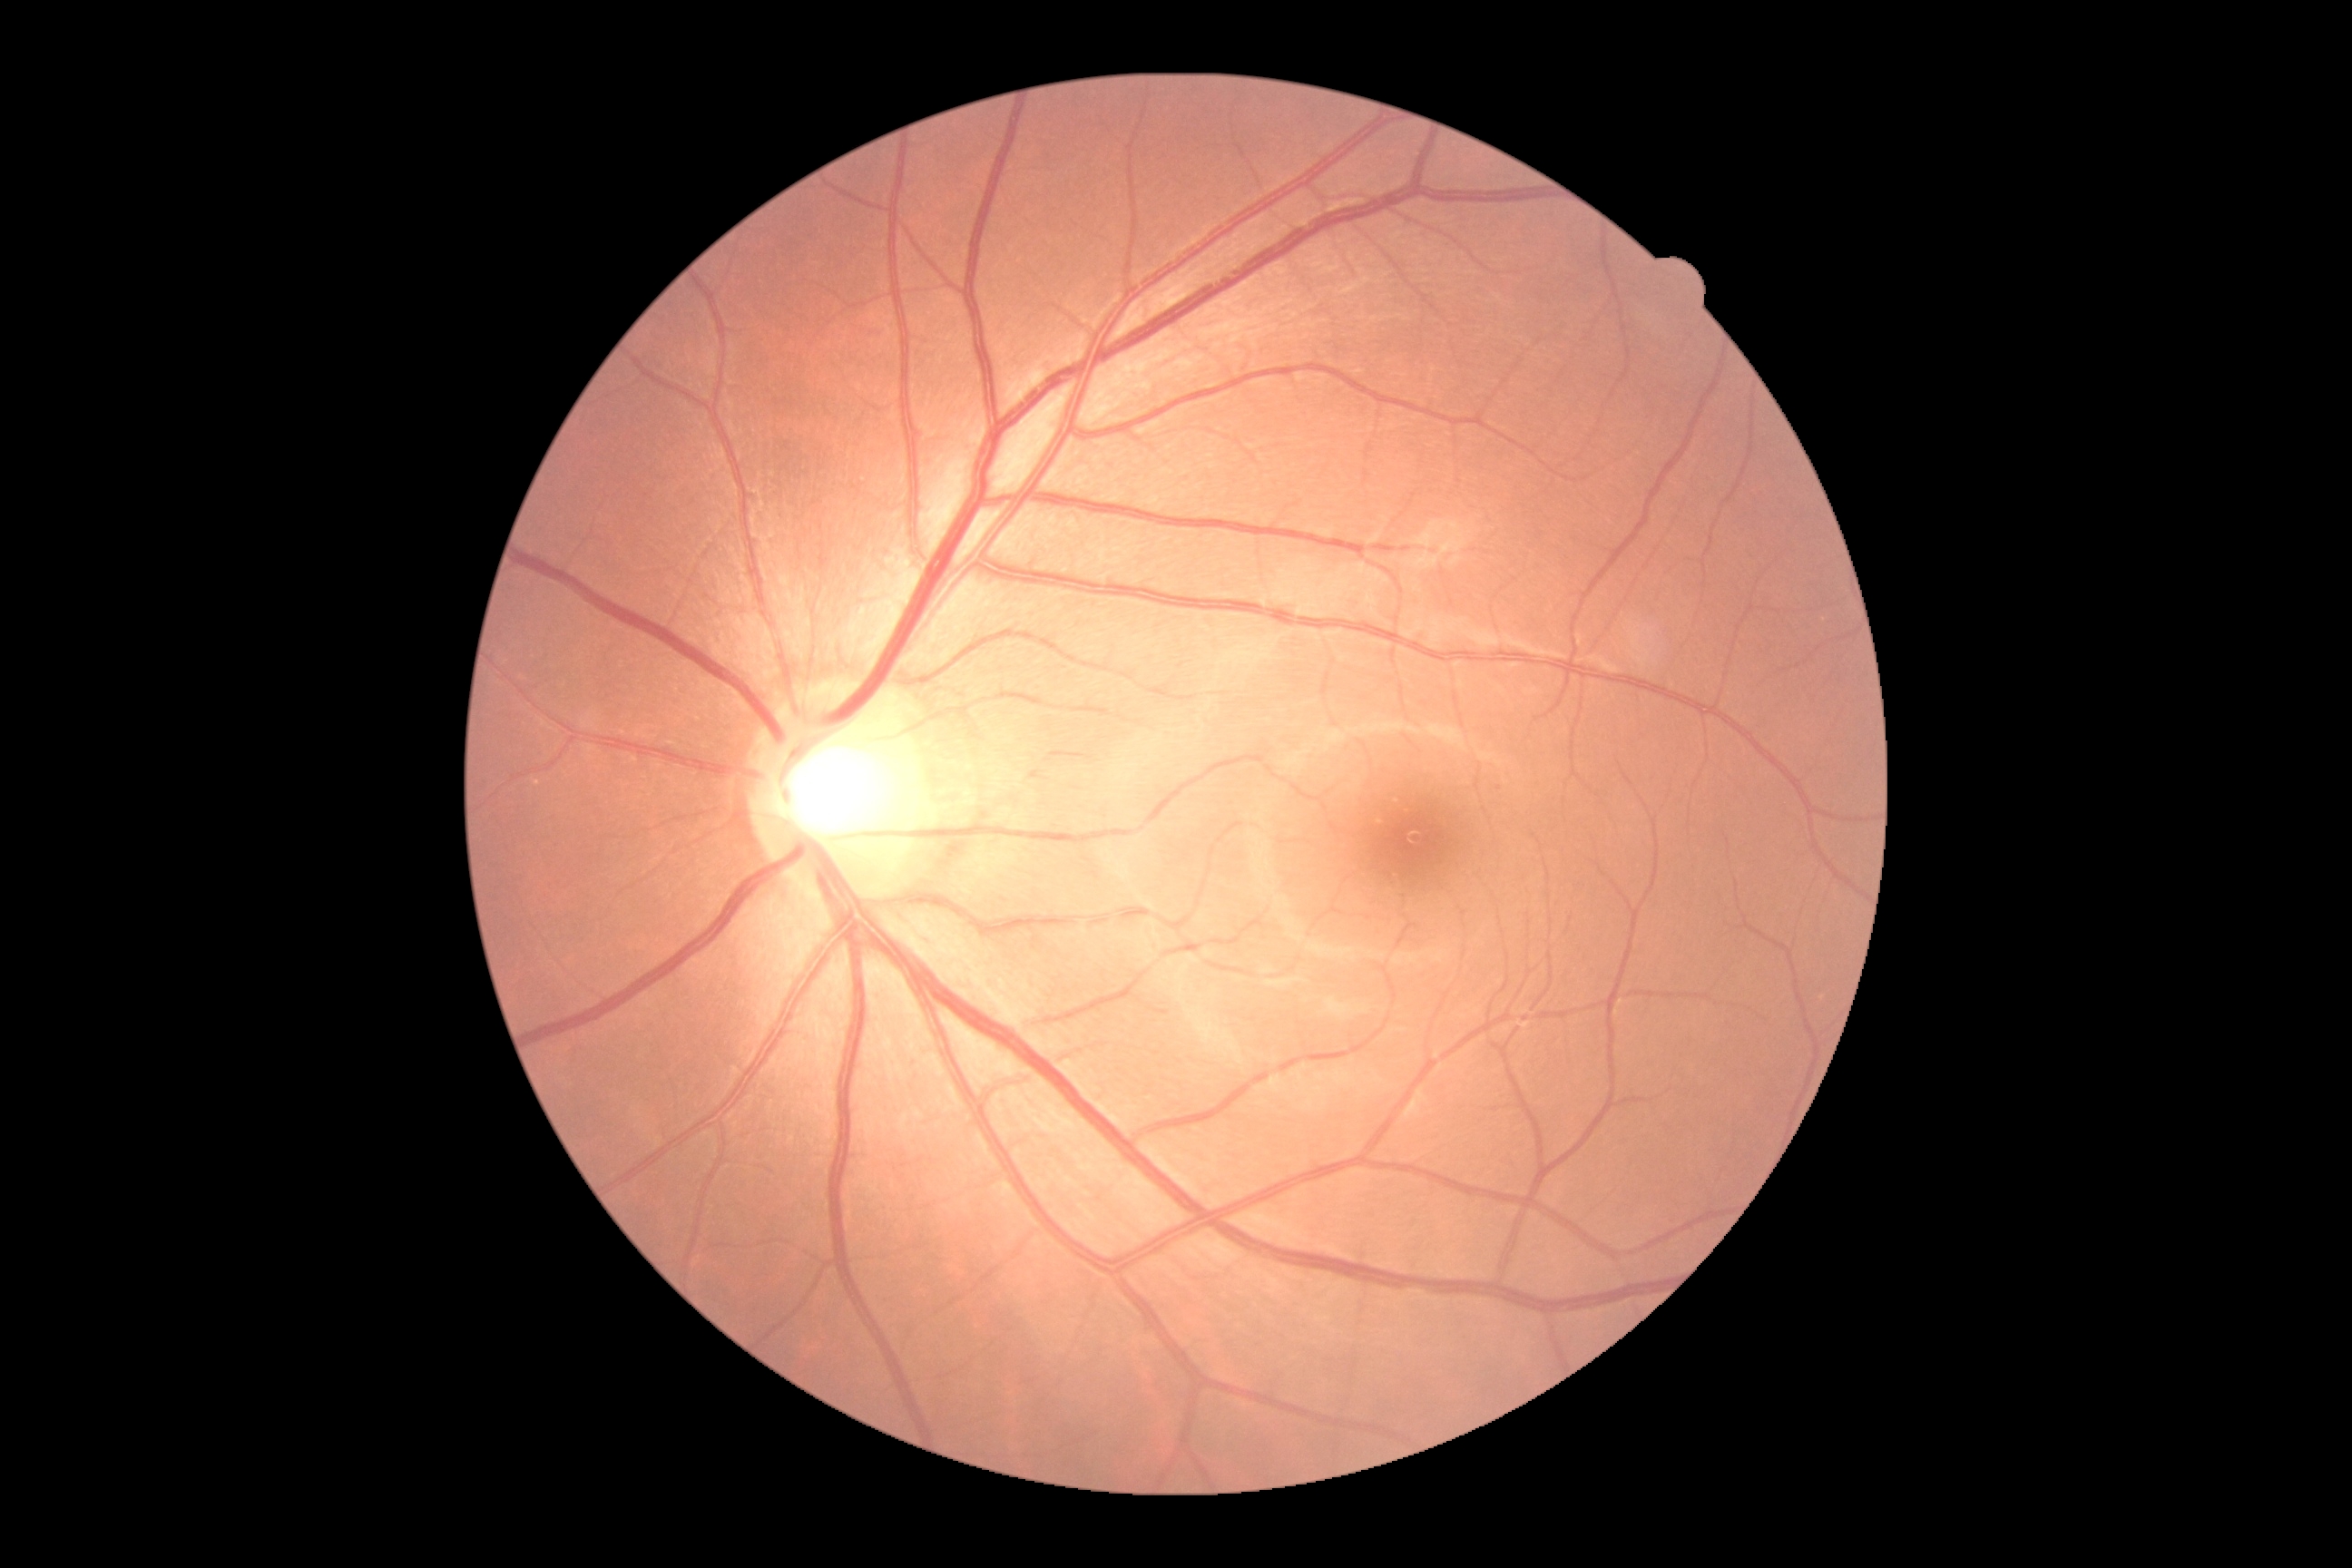 Diabetic retinopathy (DR): grade 0.